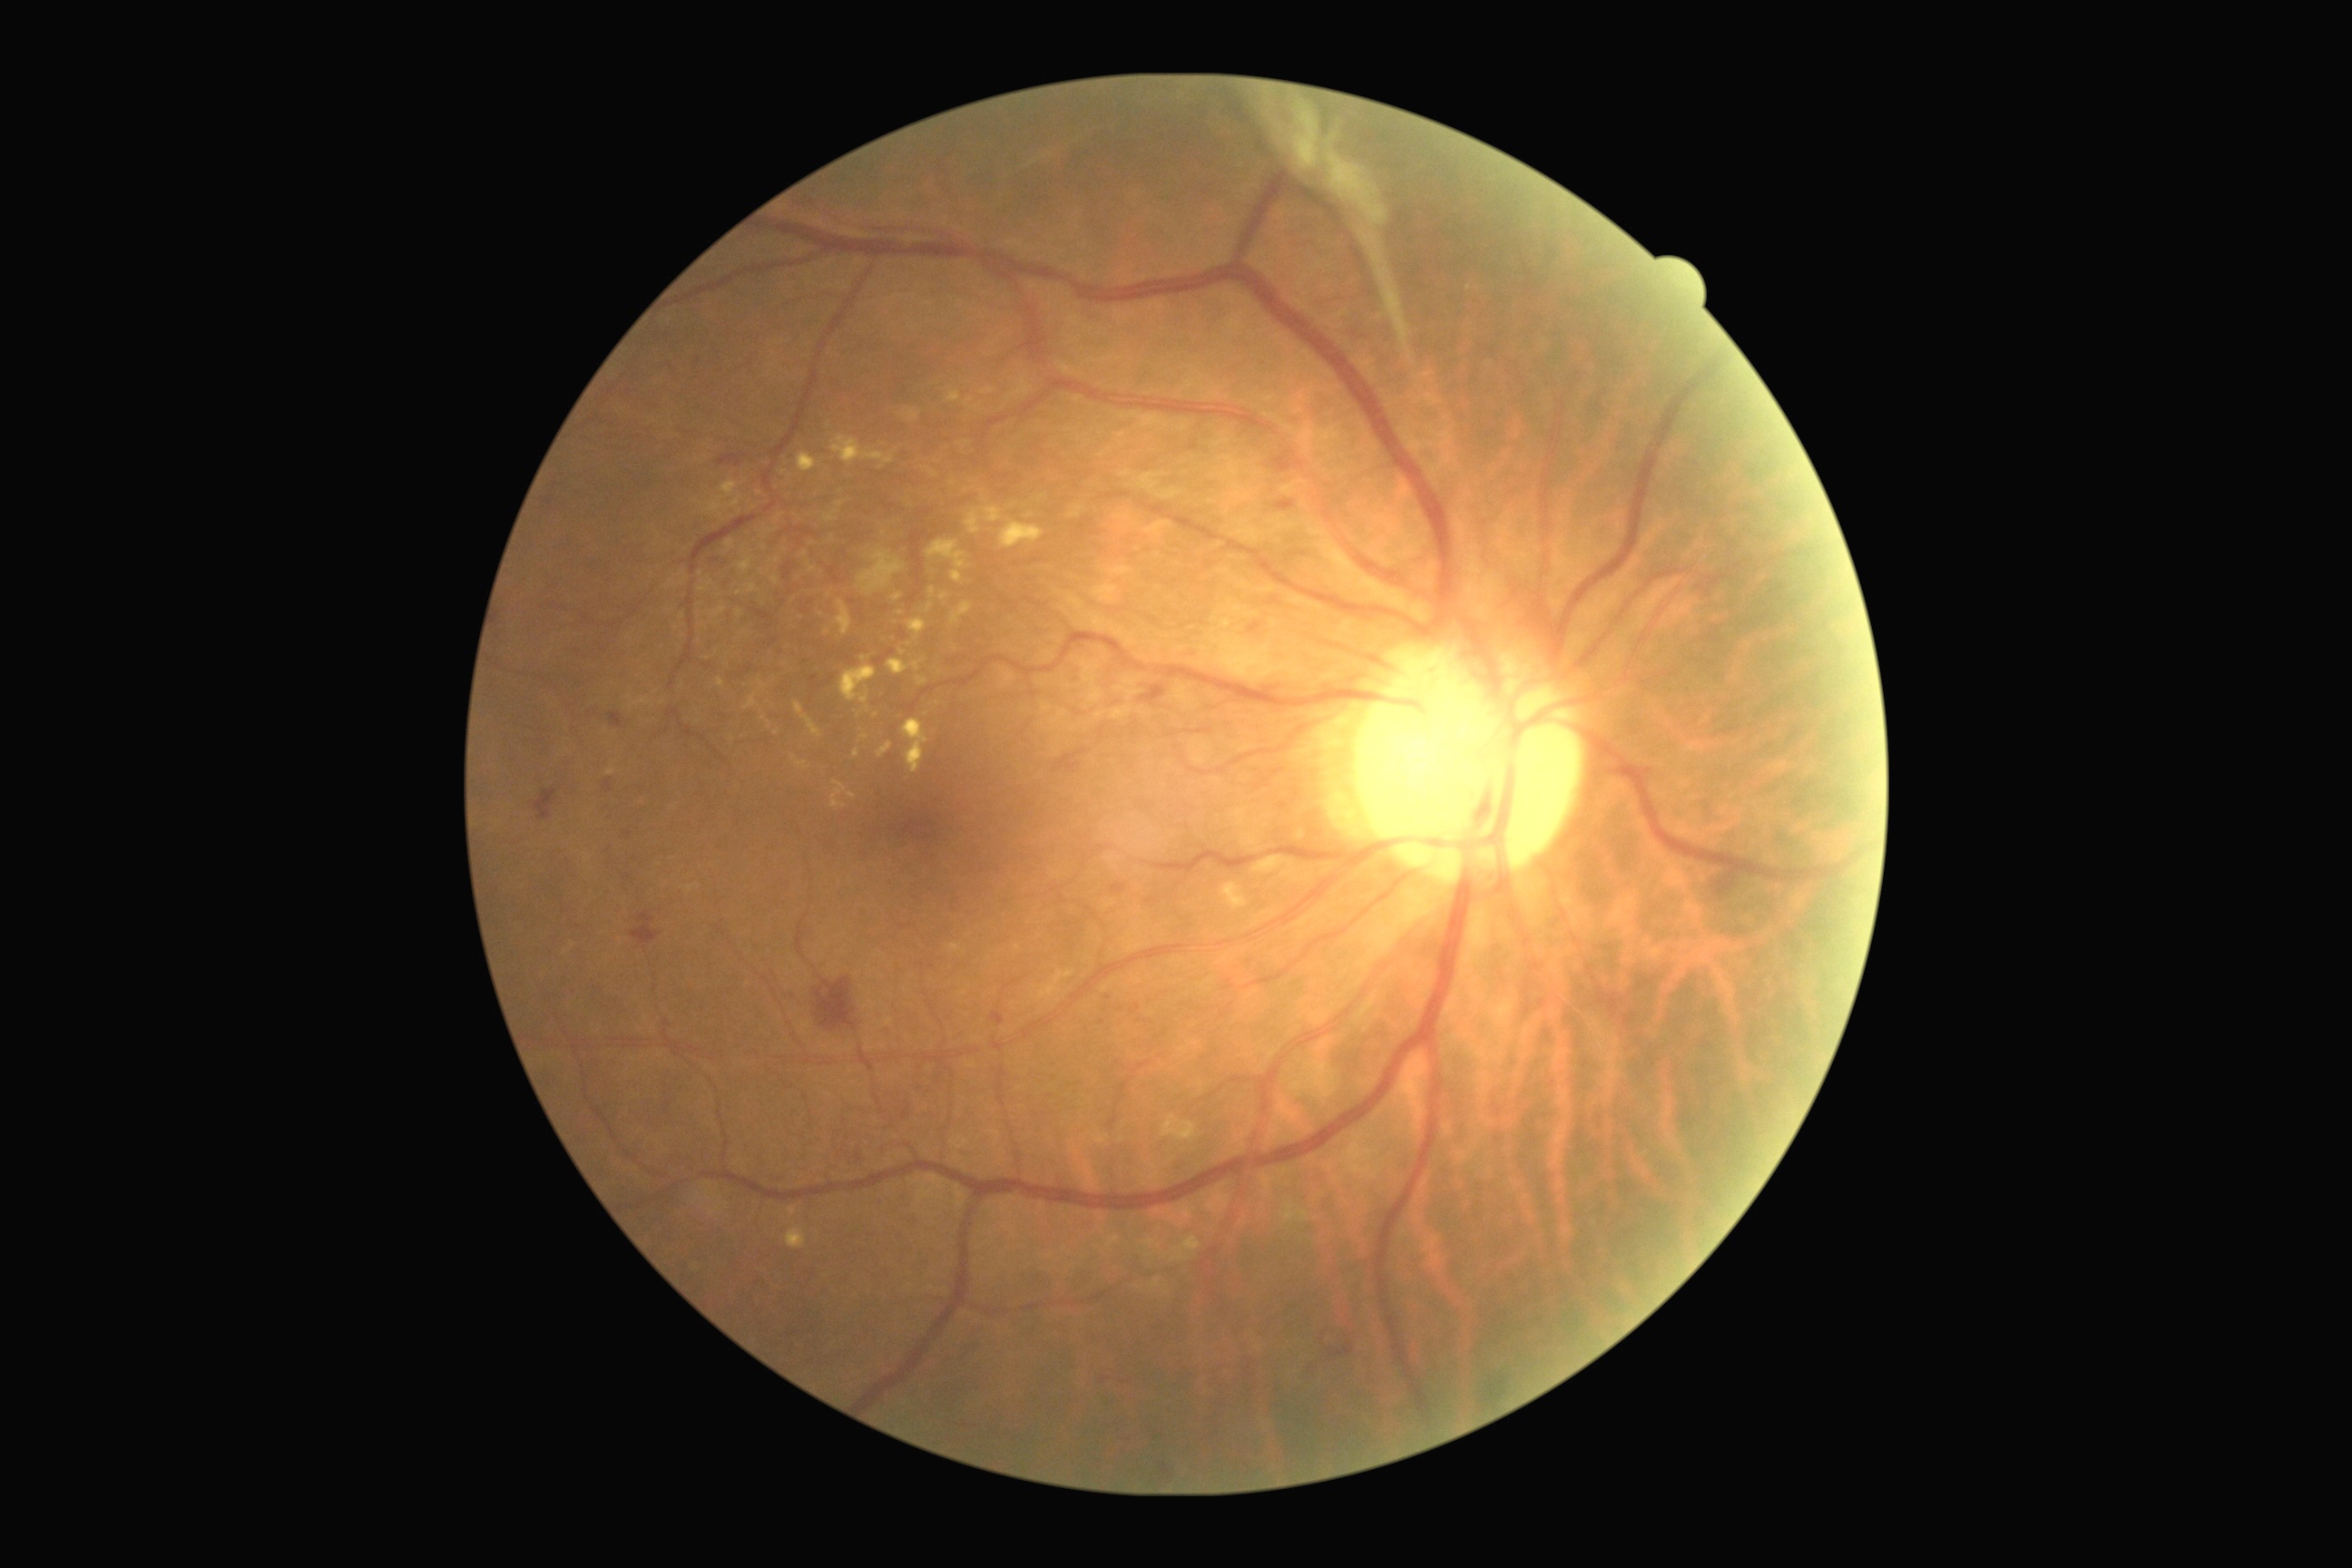 Diabetic retinopathy: grade 4 (PDR); proliferative diabetic retinopathy. Hard exudates include those at [807,562,816,574] | [836,502,845,507] | [941,593,948,602] | [861,656,870,663] | [1001,522,1044,549] | [774,513,785,522] | [1170,1237,1200,1262] | [950,603,972,625] | [714,607,727,618] | [908,618,926,640] | [946,387,961,404] | [858,549,906,596] | [607,769,616,776] | [901,407,921,422]. Hard exudates (small, approximate centers) near 763:574 | 805:555 | 902:652 | 784:473 | 758:493 | 926:714.